Image size 2368x1568.
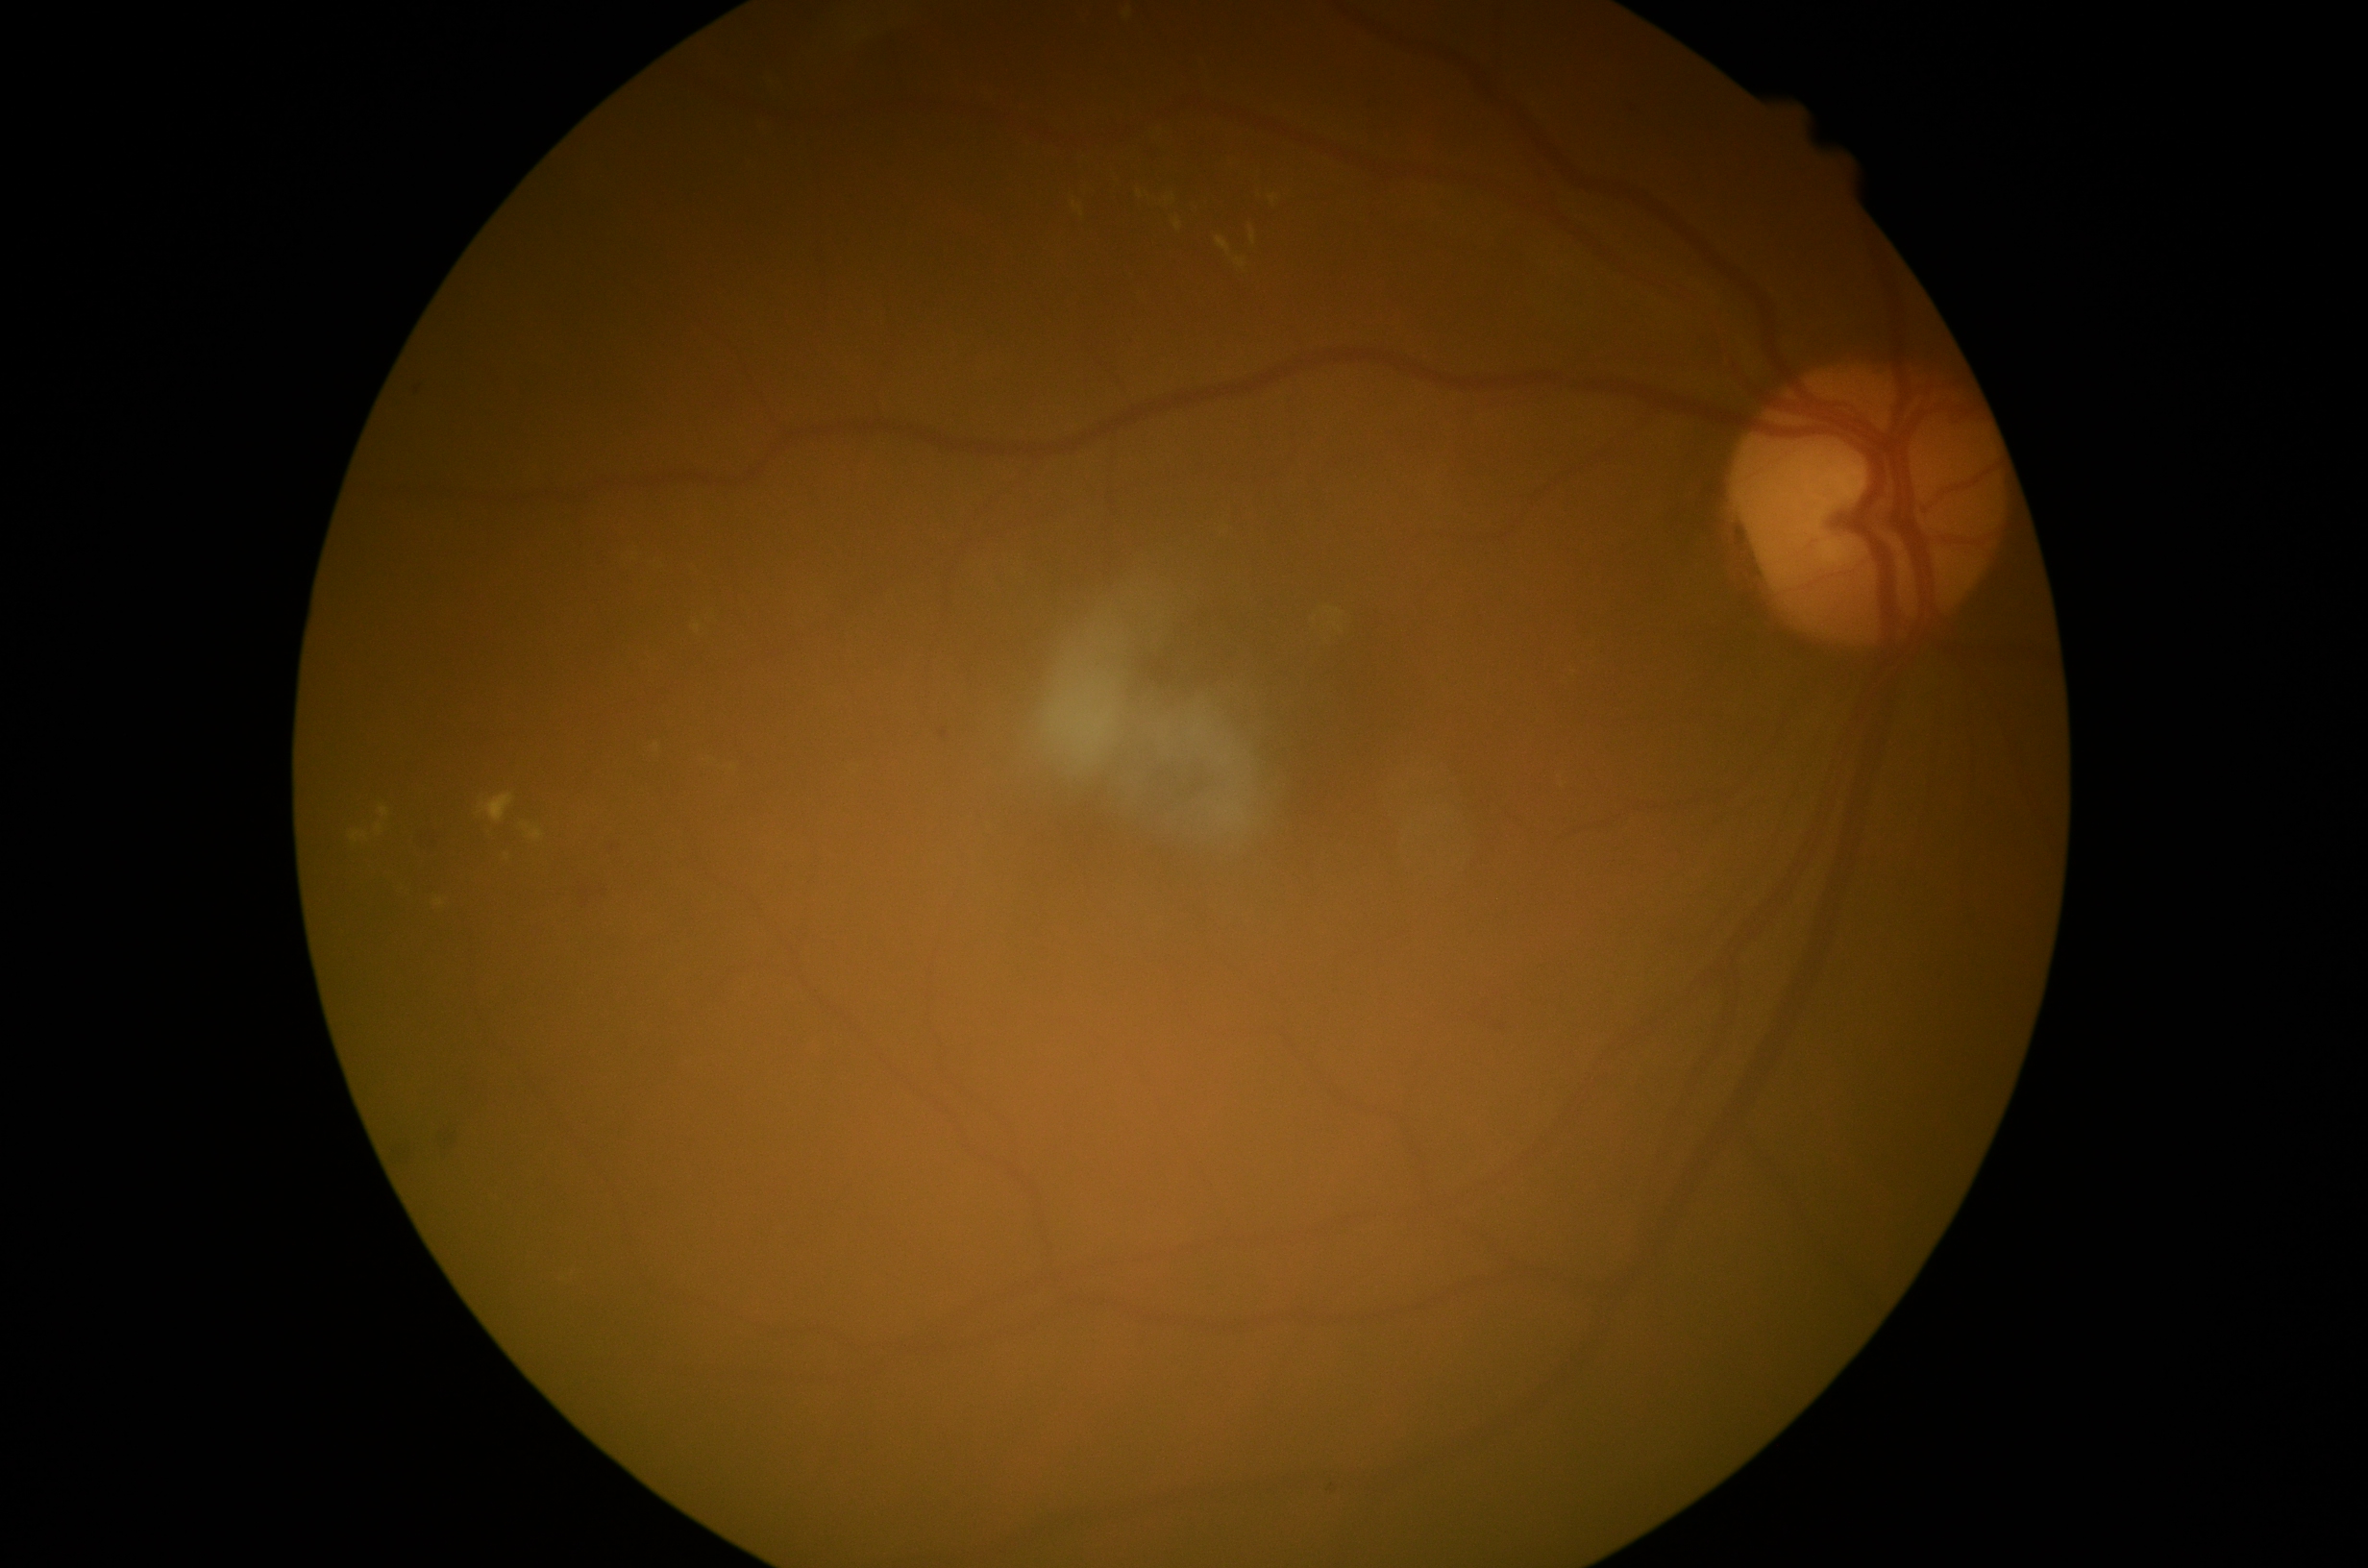
Diabetic retinopathy severity: moderate non-proliferative diabetic retinopathy (grade 2).